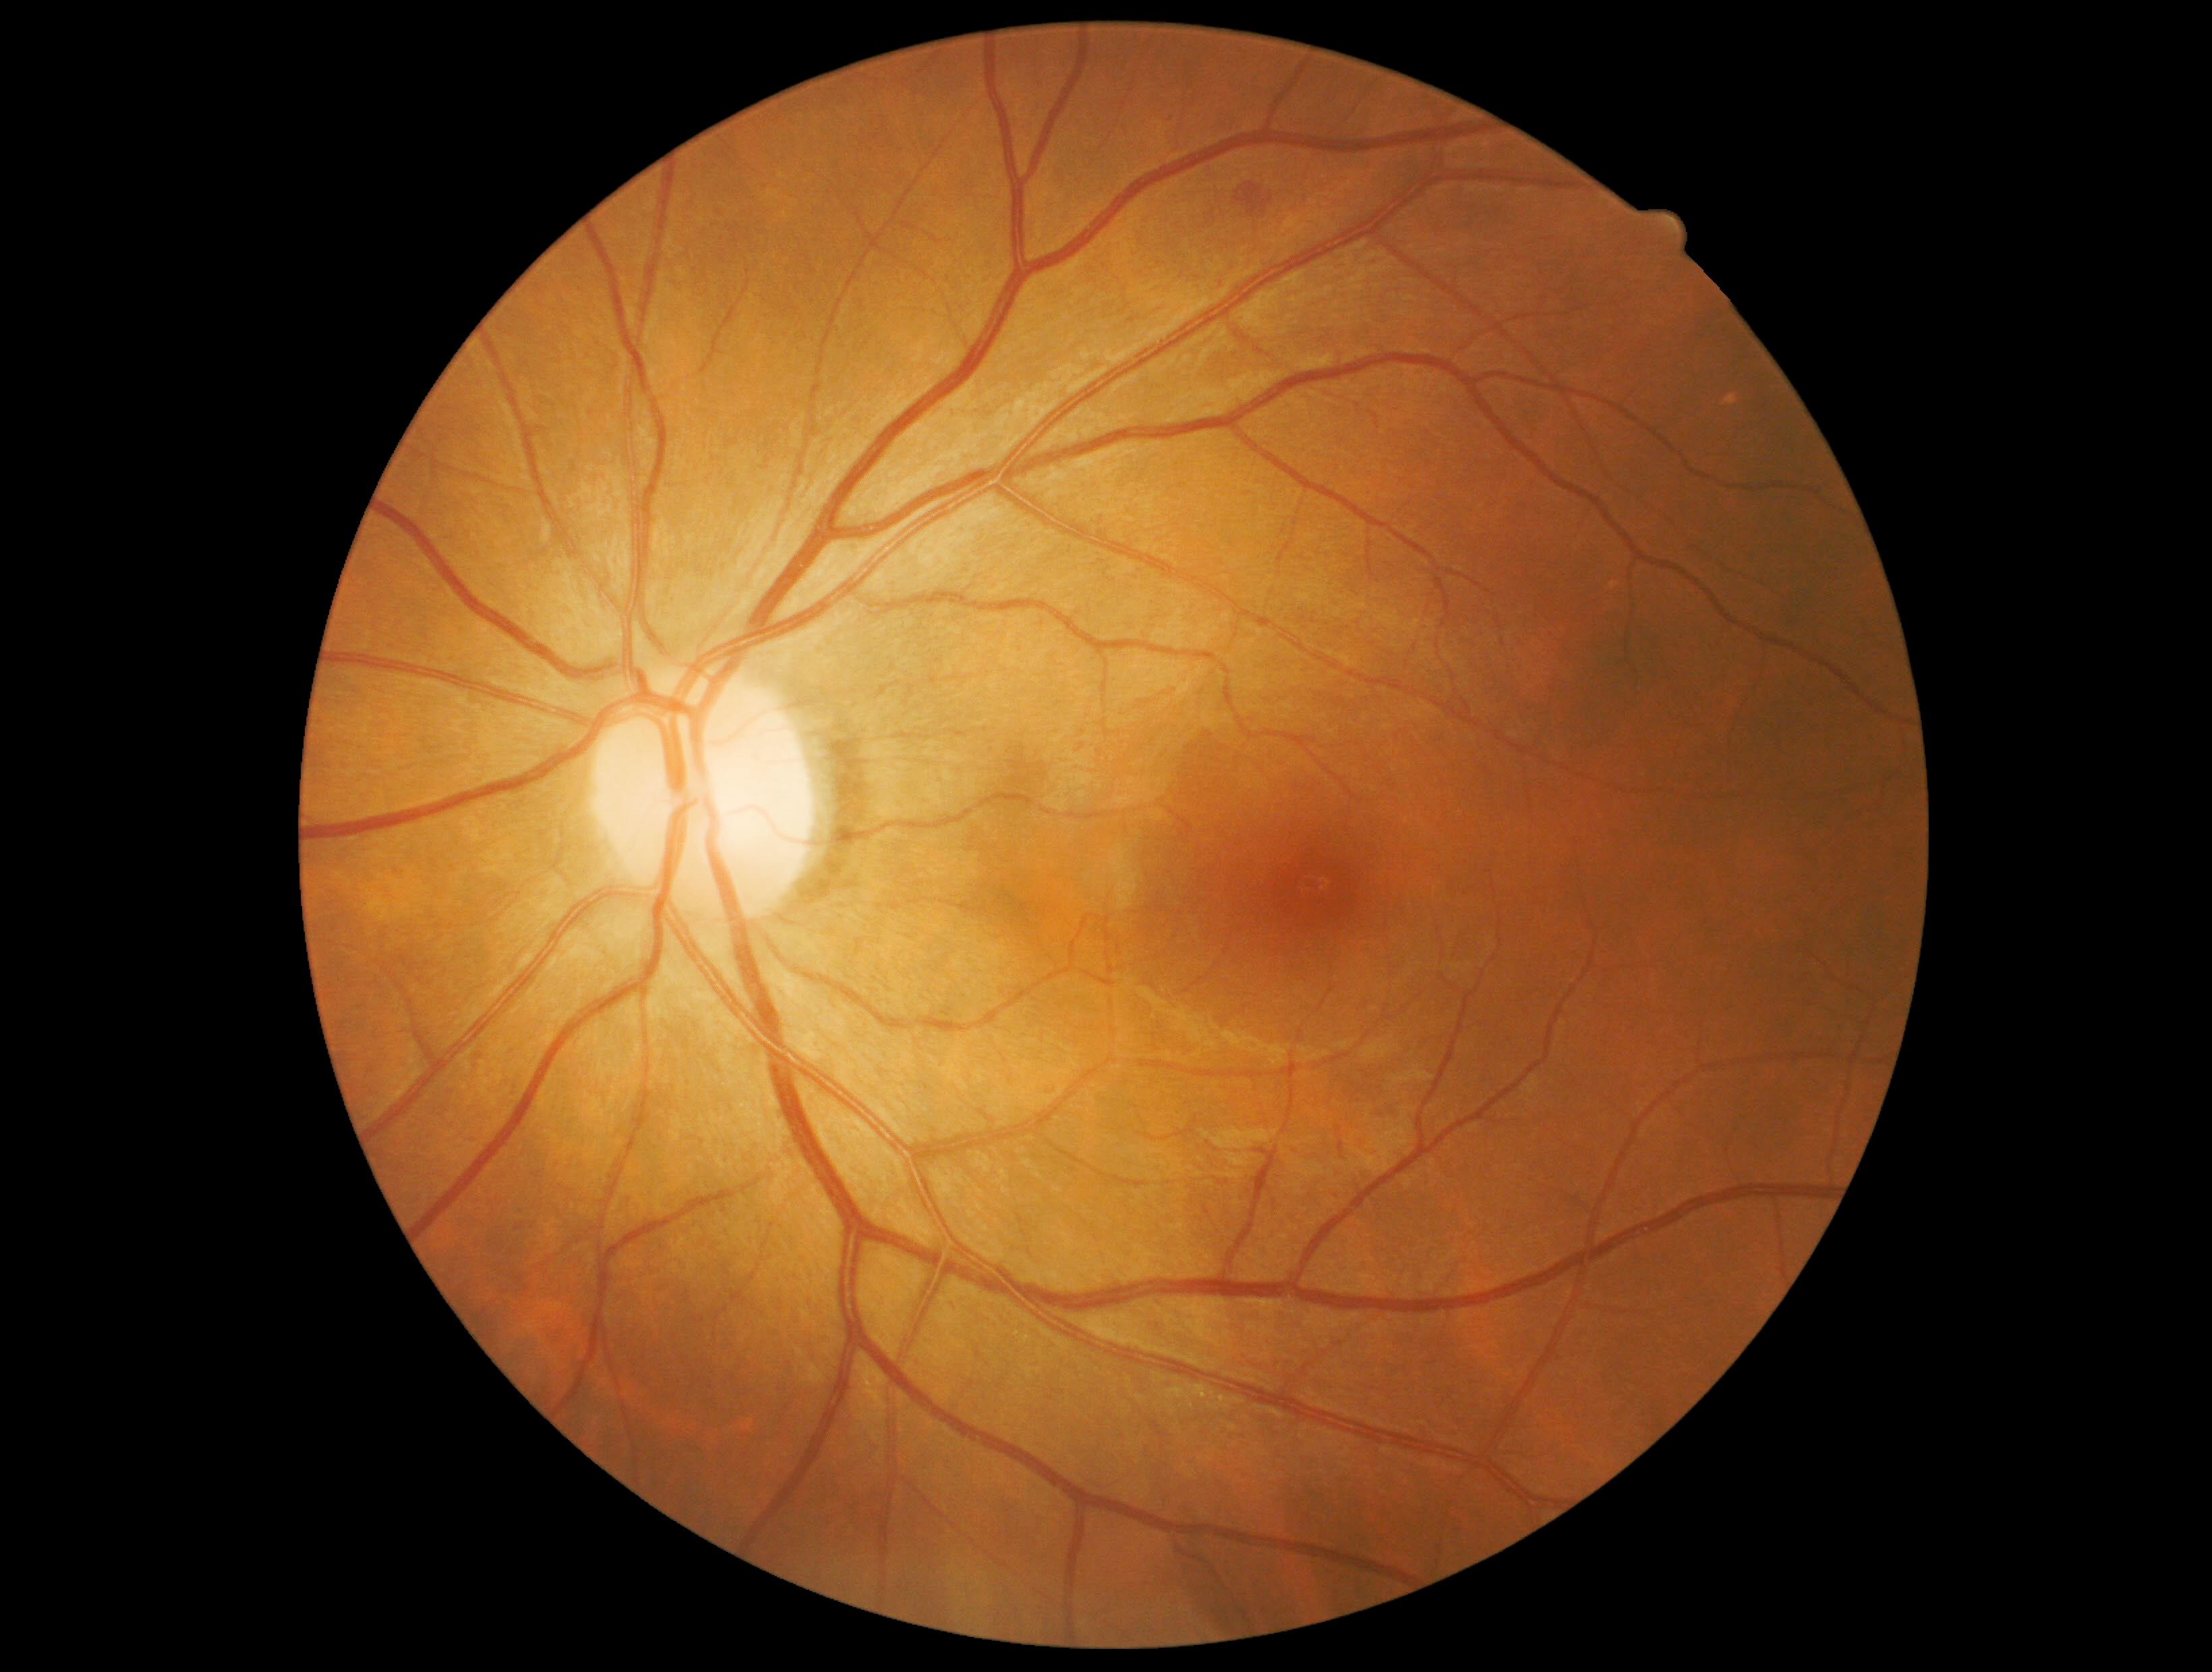 Diabetic retinopathy (DR): grade 2 (moderate NPDR).